Camera: NIDEK AFC-230. 45° FOV:
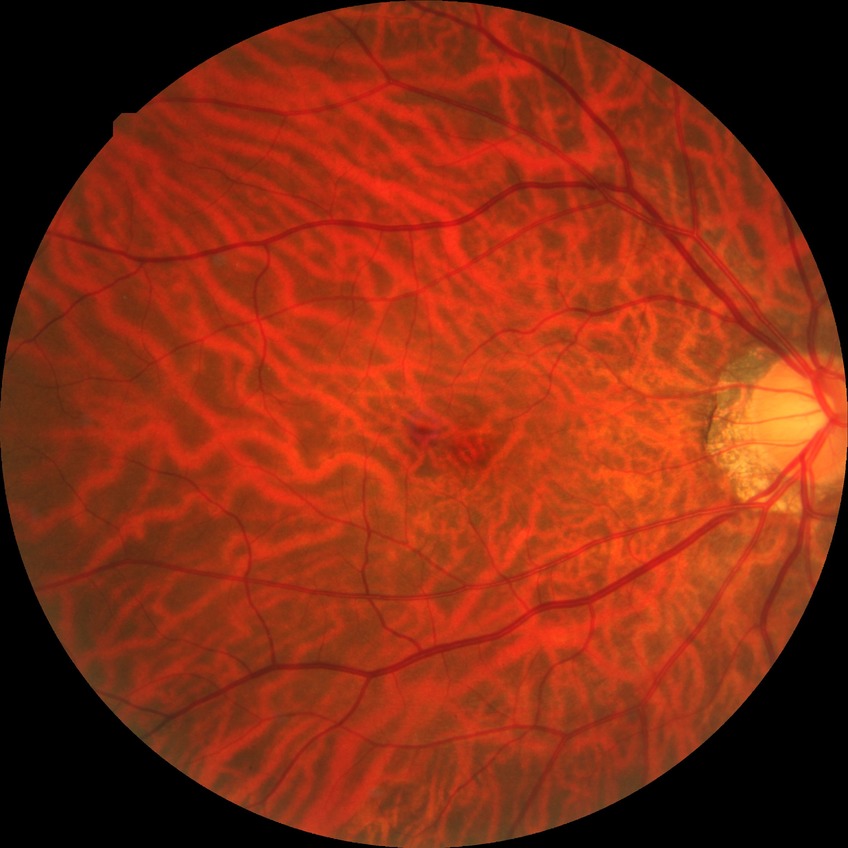
retinopathy stage@no diabetic retinopathy.